FOV: 45 degrees
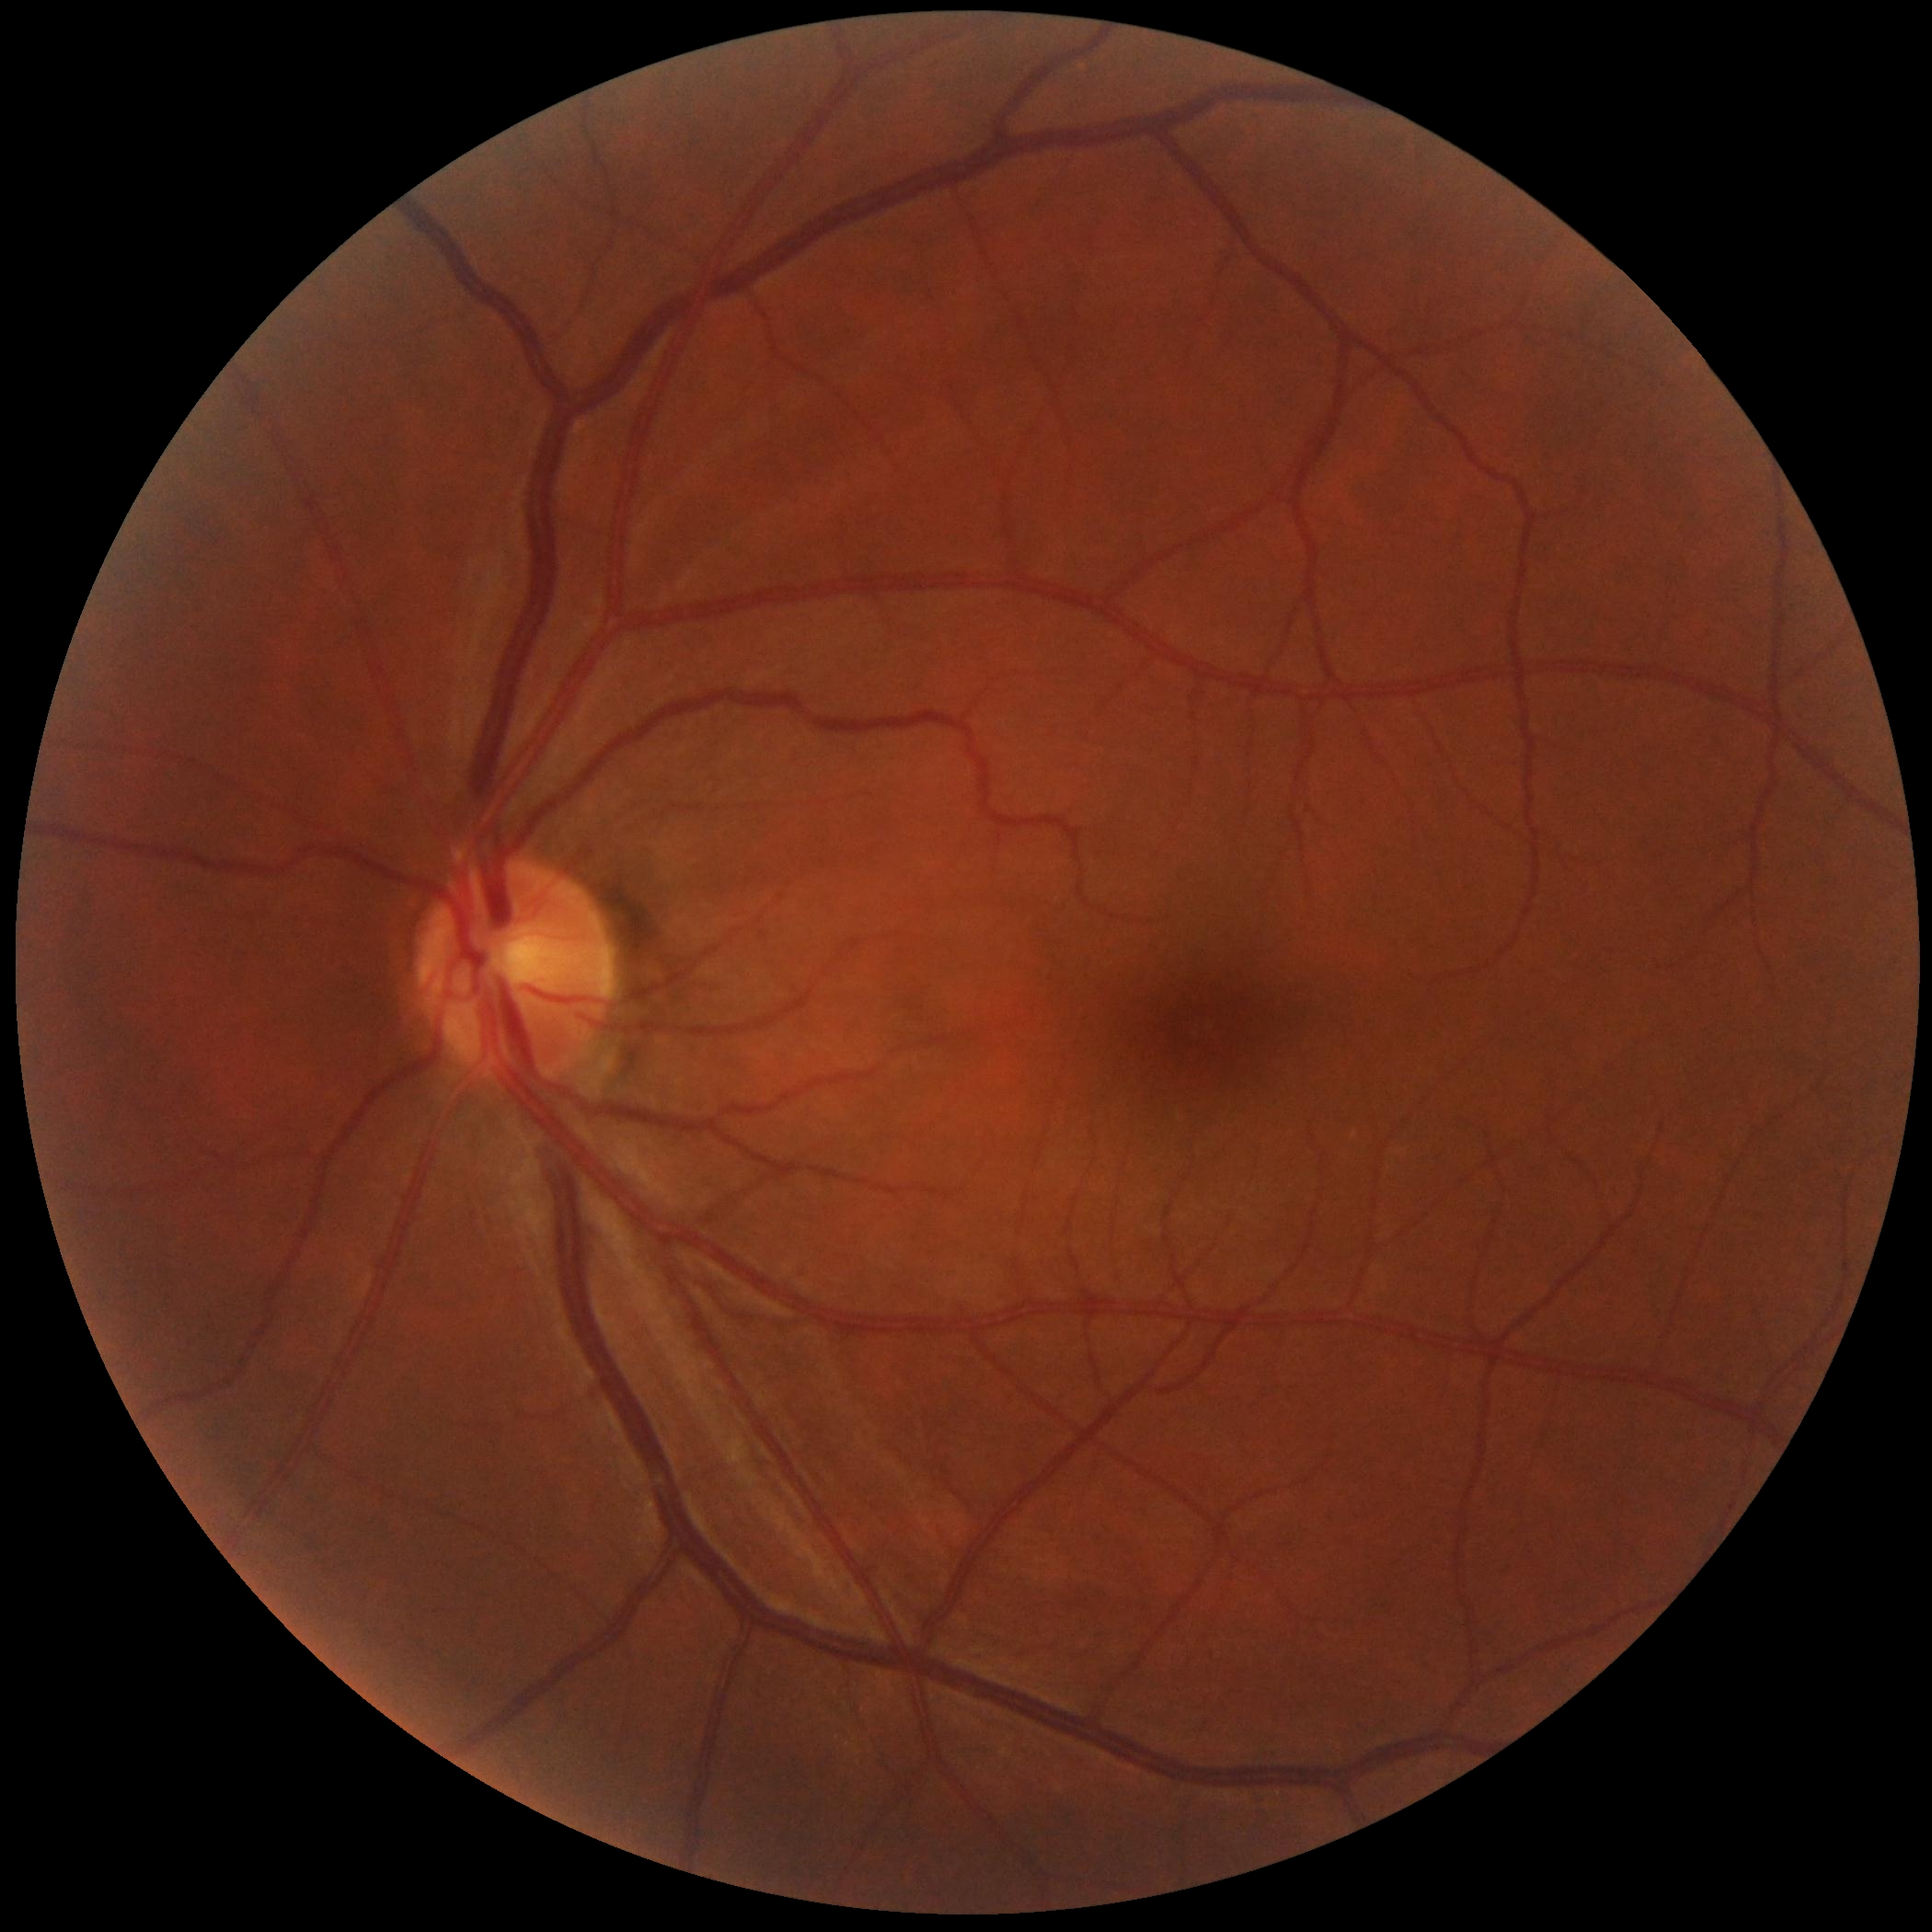

DR grade: no apparent retinopathy (0).